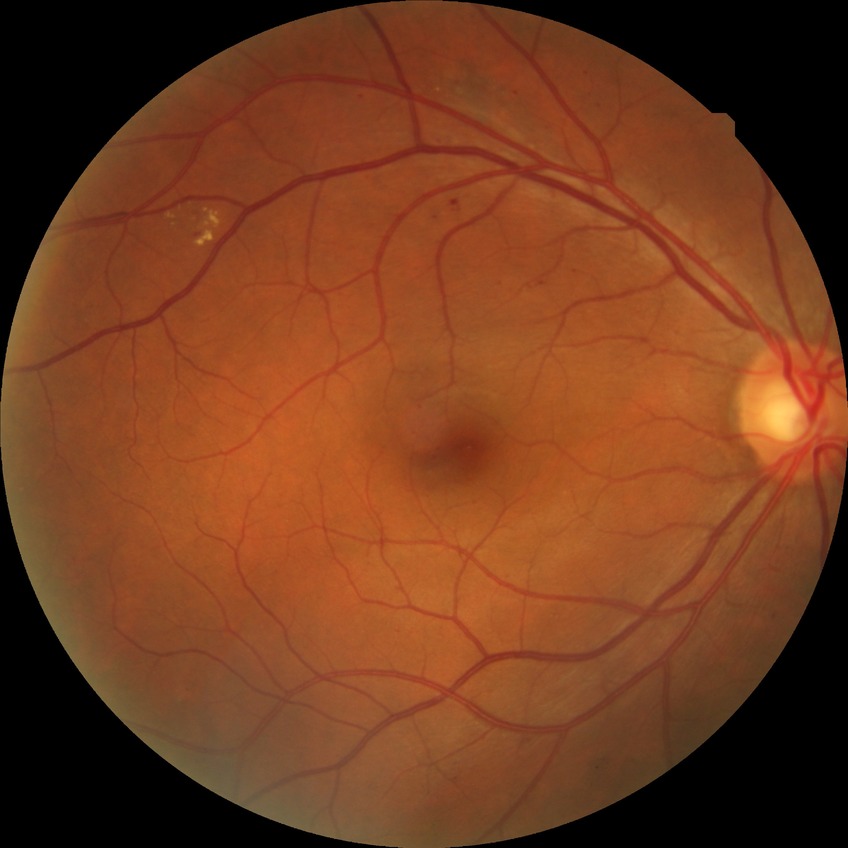
diabetic retinopathy (DR)@simple diabetic retinopathy (SDR).